Captured with the Natus RetCam Envision (130° field of view); 1440 by 1080 pixels; wide-field contact fundus photograph of an infant
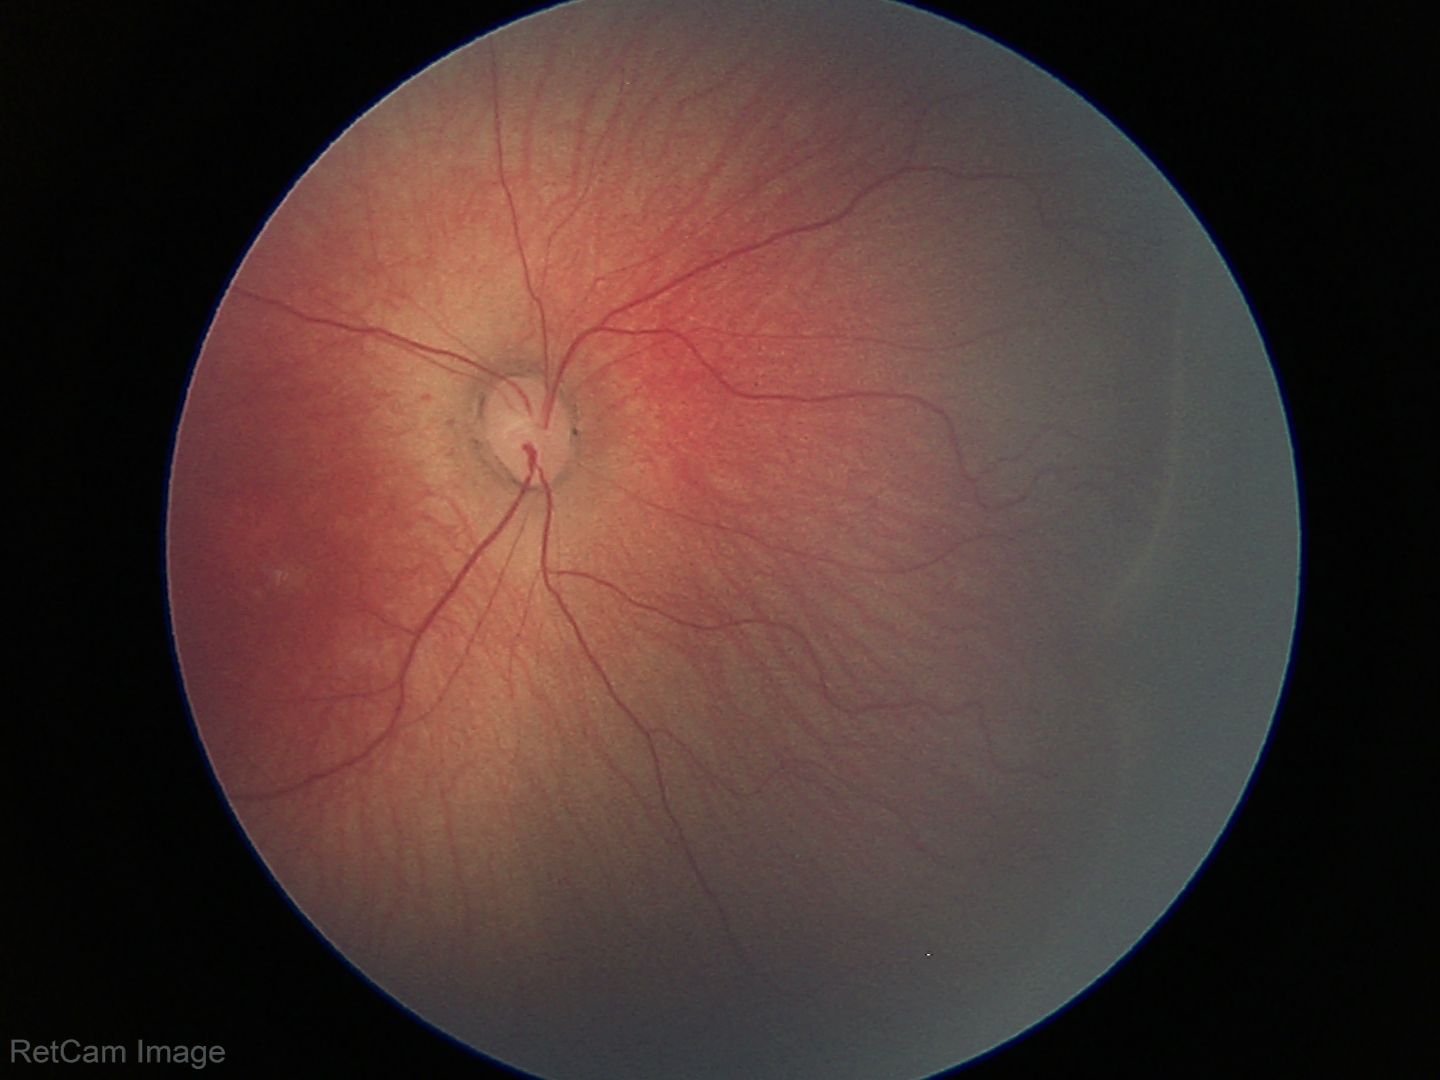
Screening examination consistent with retinopathy of prematurity (ROP) stage 1.